640 x 480 pixels; wide-field fundus photograph of an infant; camera: Clarity RetCam 3 (130° FOV)
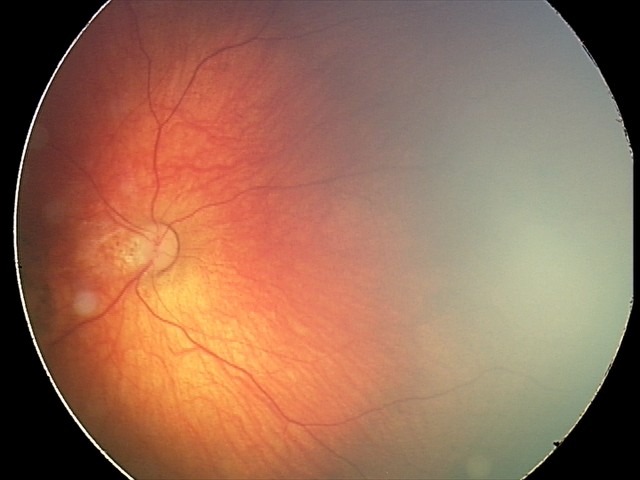
Diagnosis: toxoplasmosis chorioretinitis.